Davis DR grading
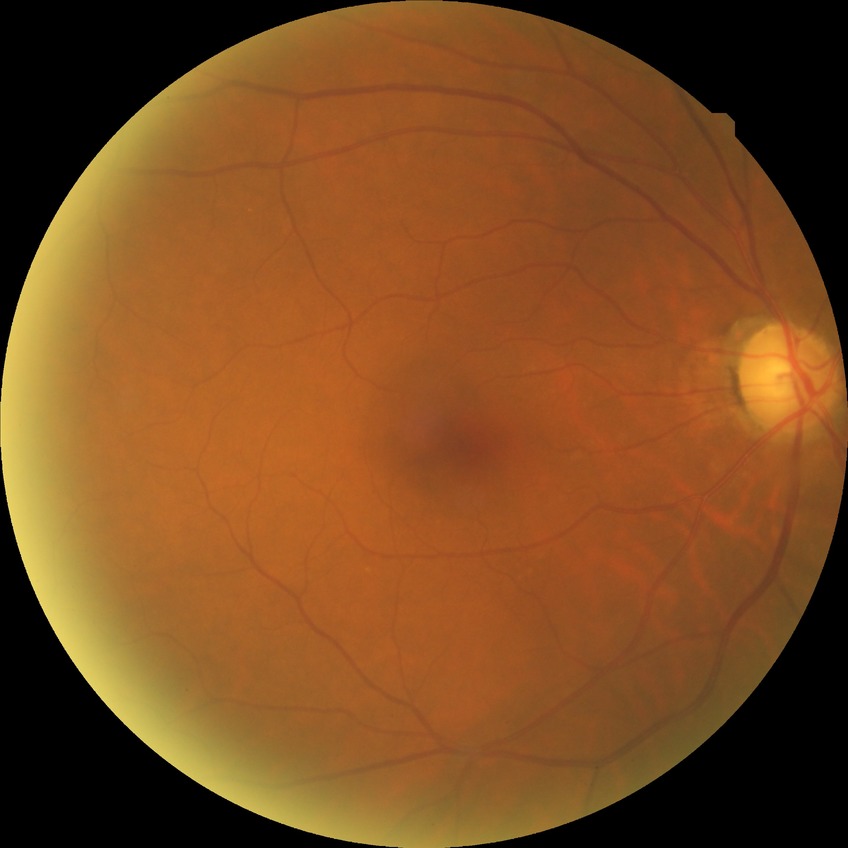
Diabetic retinopathy (DR): no diabetic retinopathy (NDR).